Natus RetCam Envision, 130° FOV · 1440 by 1080 pixels · wide-field fundus photograph from neonatal ROP screening — 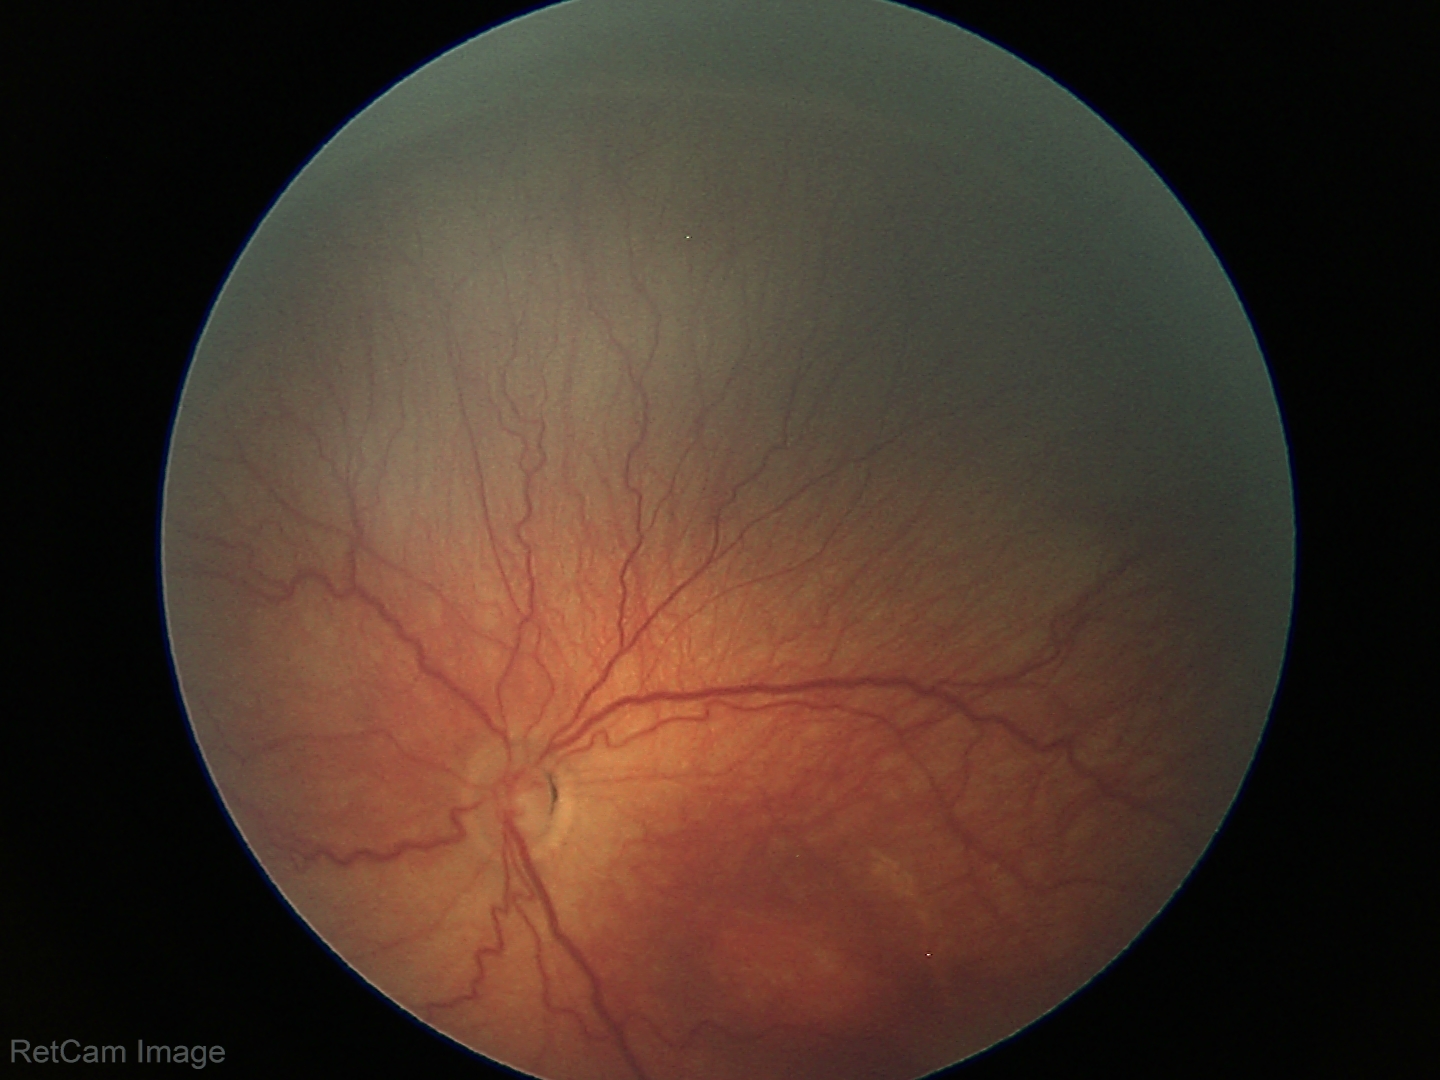 Plus disease absent.
Diagnosis from this screening exam: ROP stage 3.